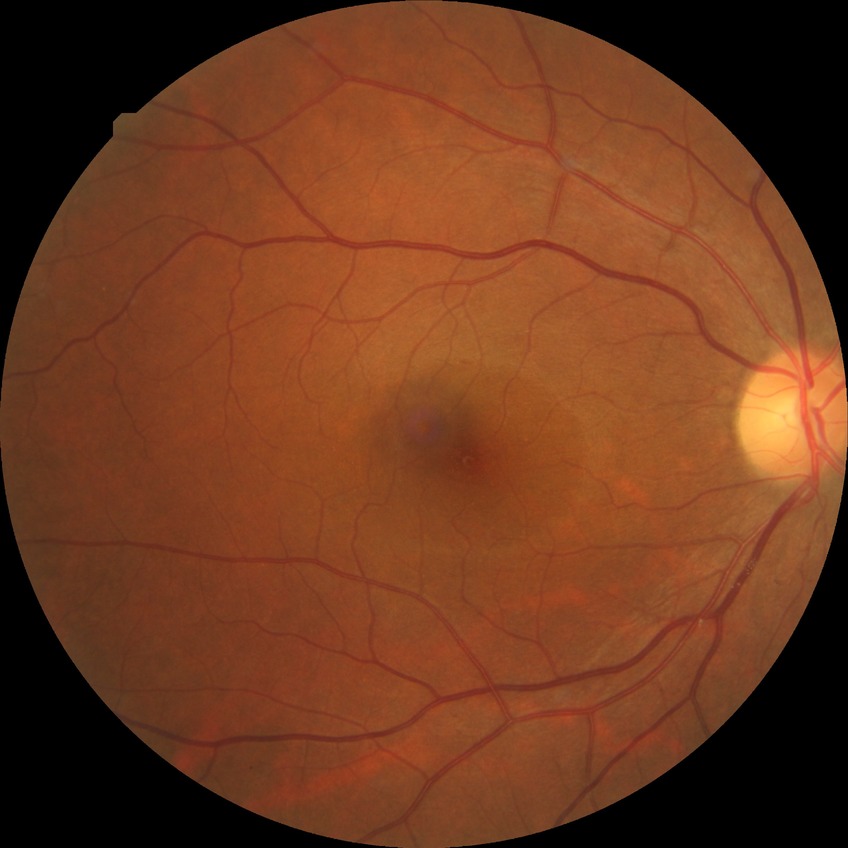 diabetic retinopathy (DR): no diabetic retinopathy (NDR).